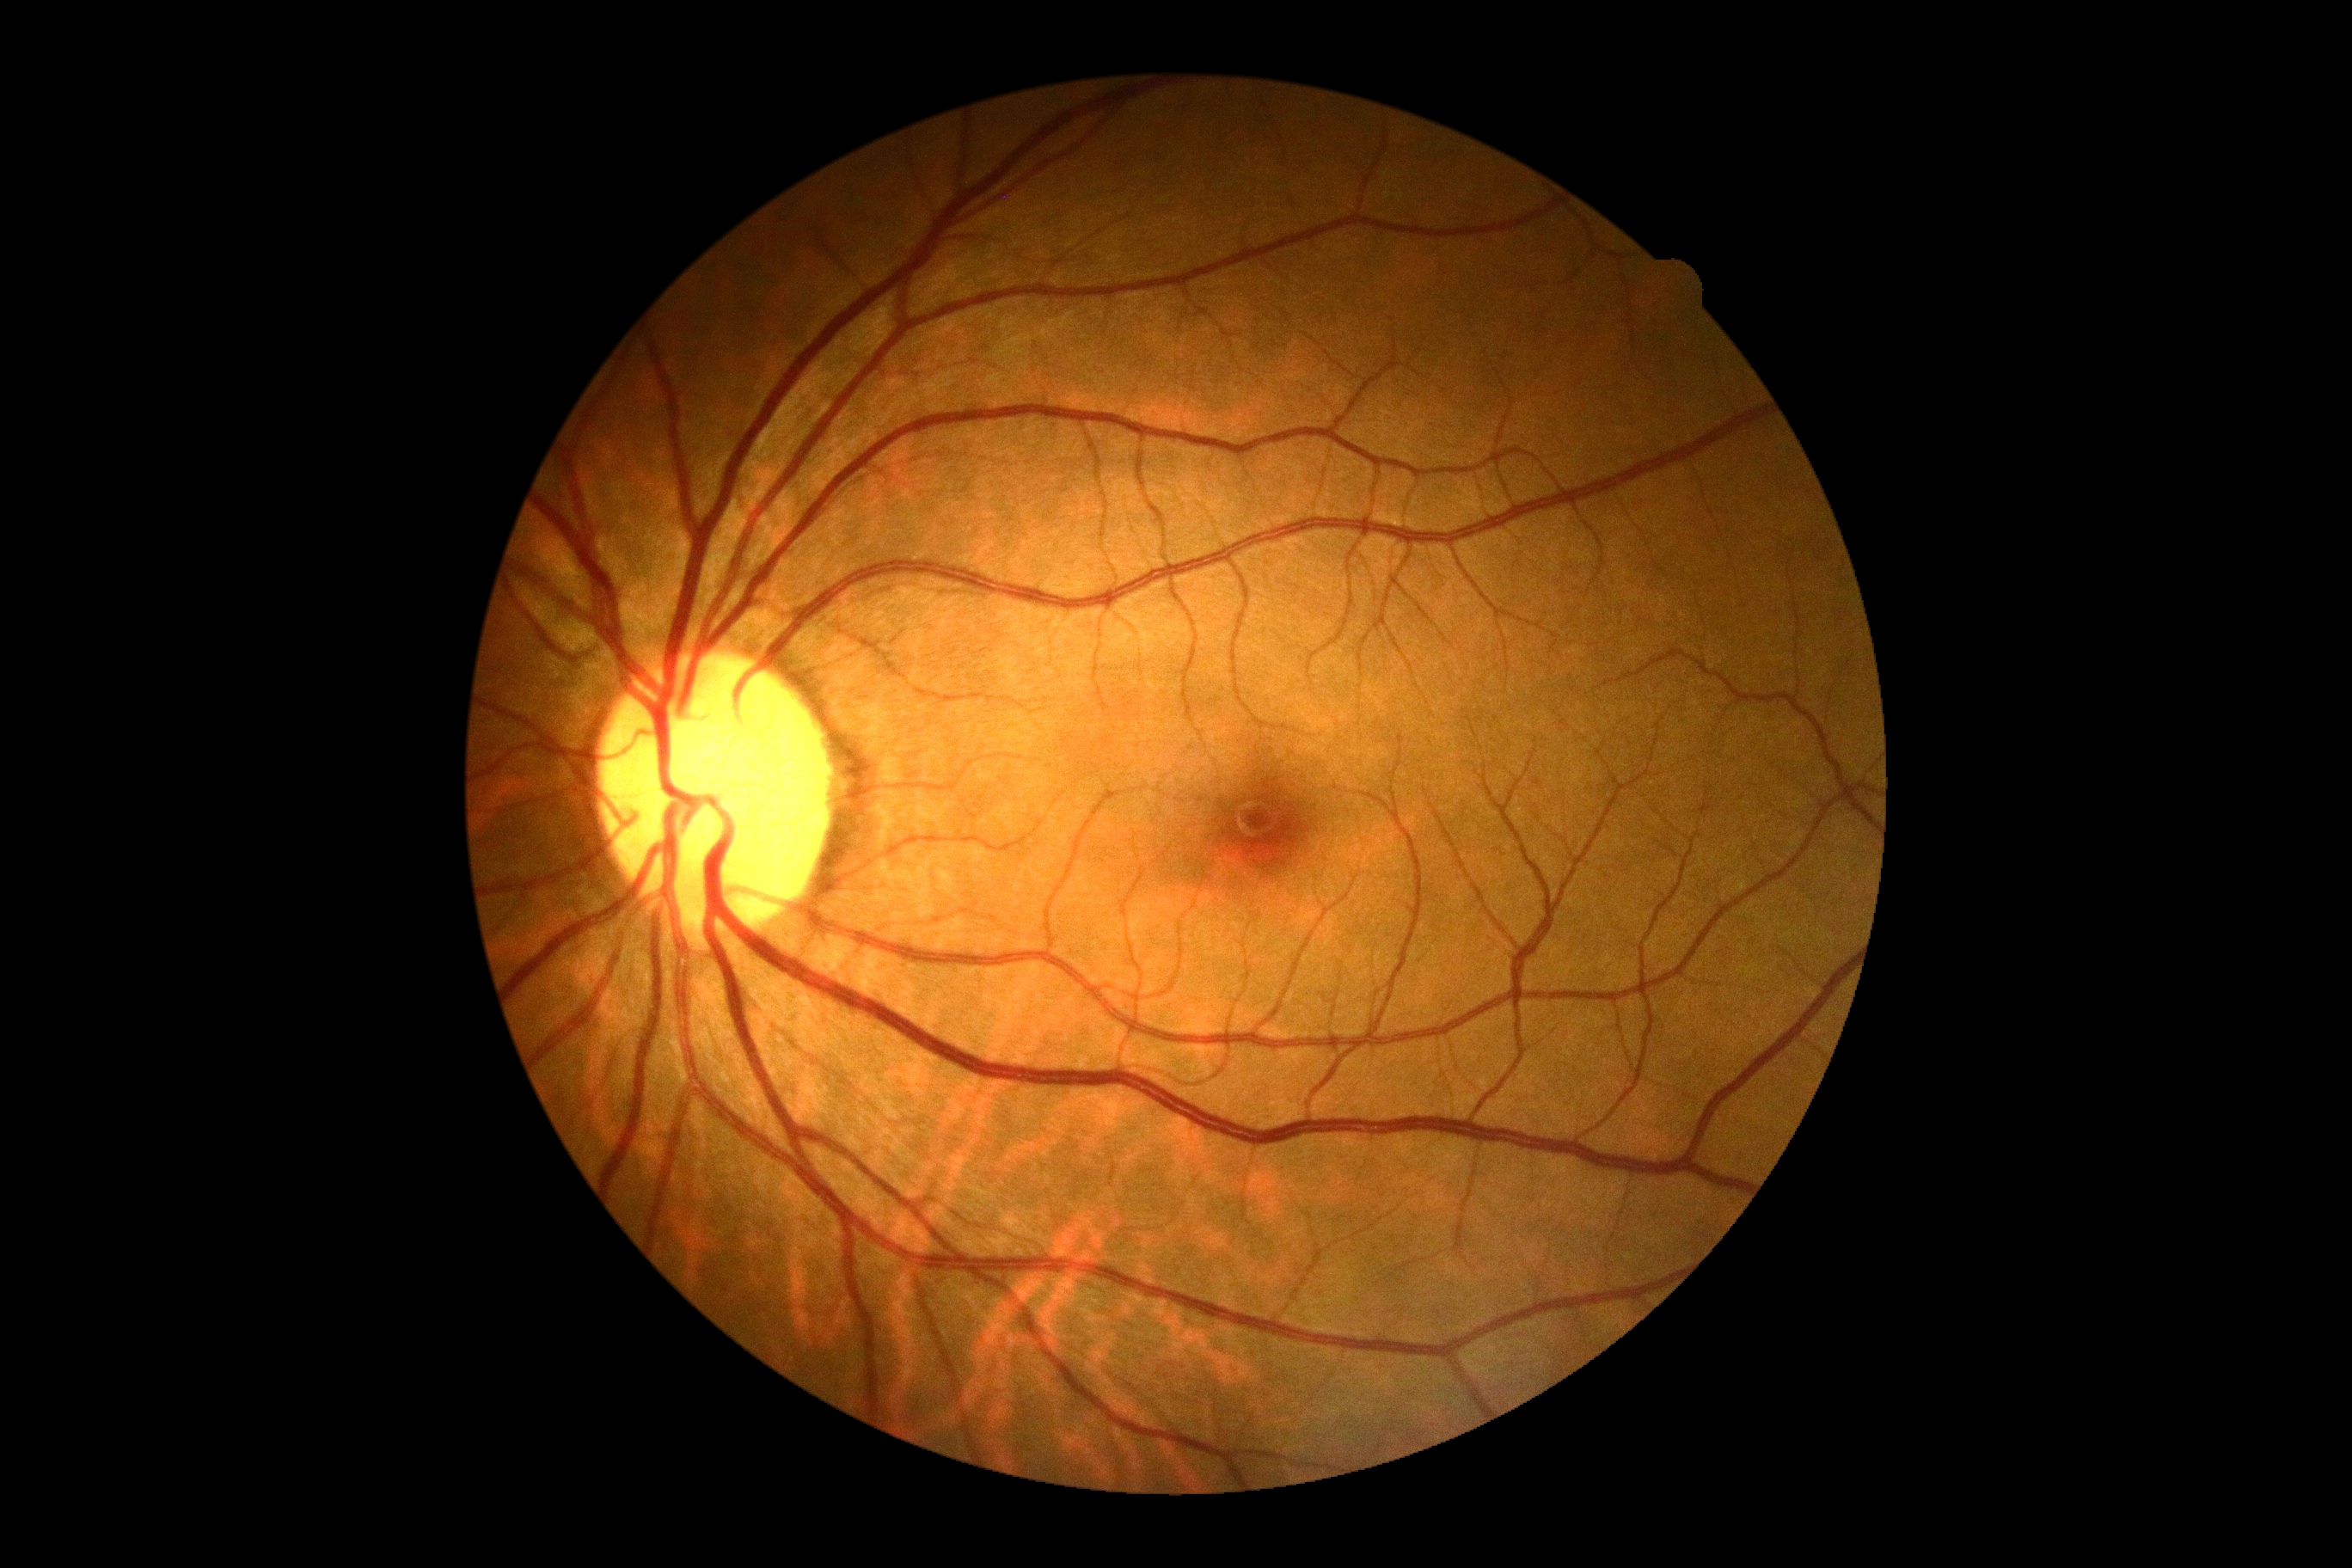 DR severity: grade 0 (no apparent retinopathy).